Retinal fundus photograph, image size 1932x1916, 45° FOV — 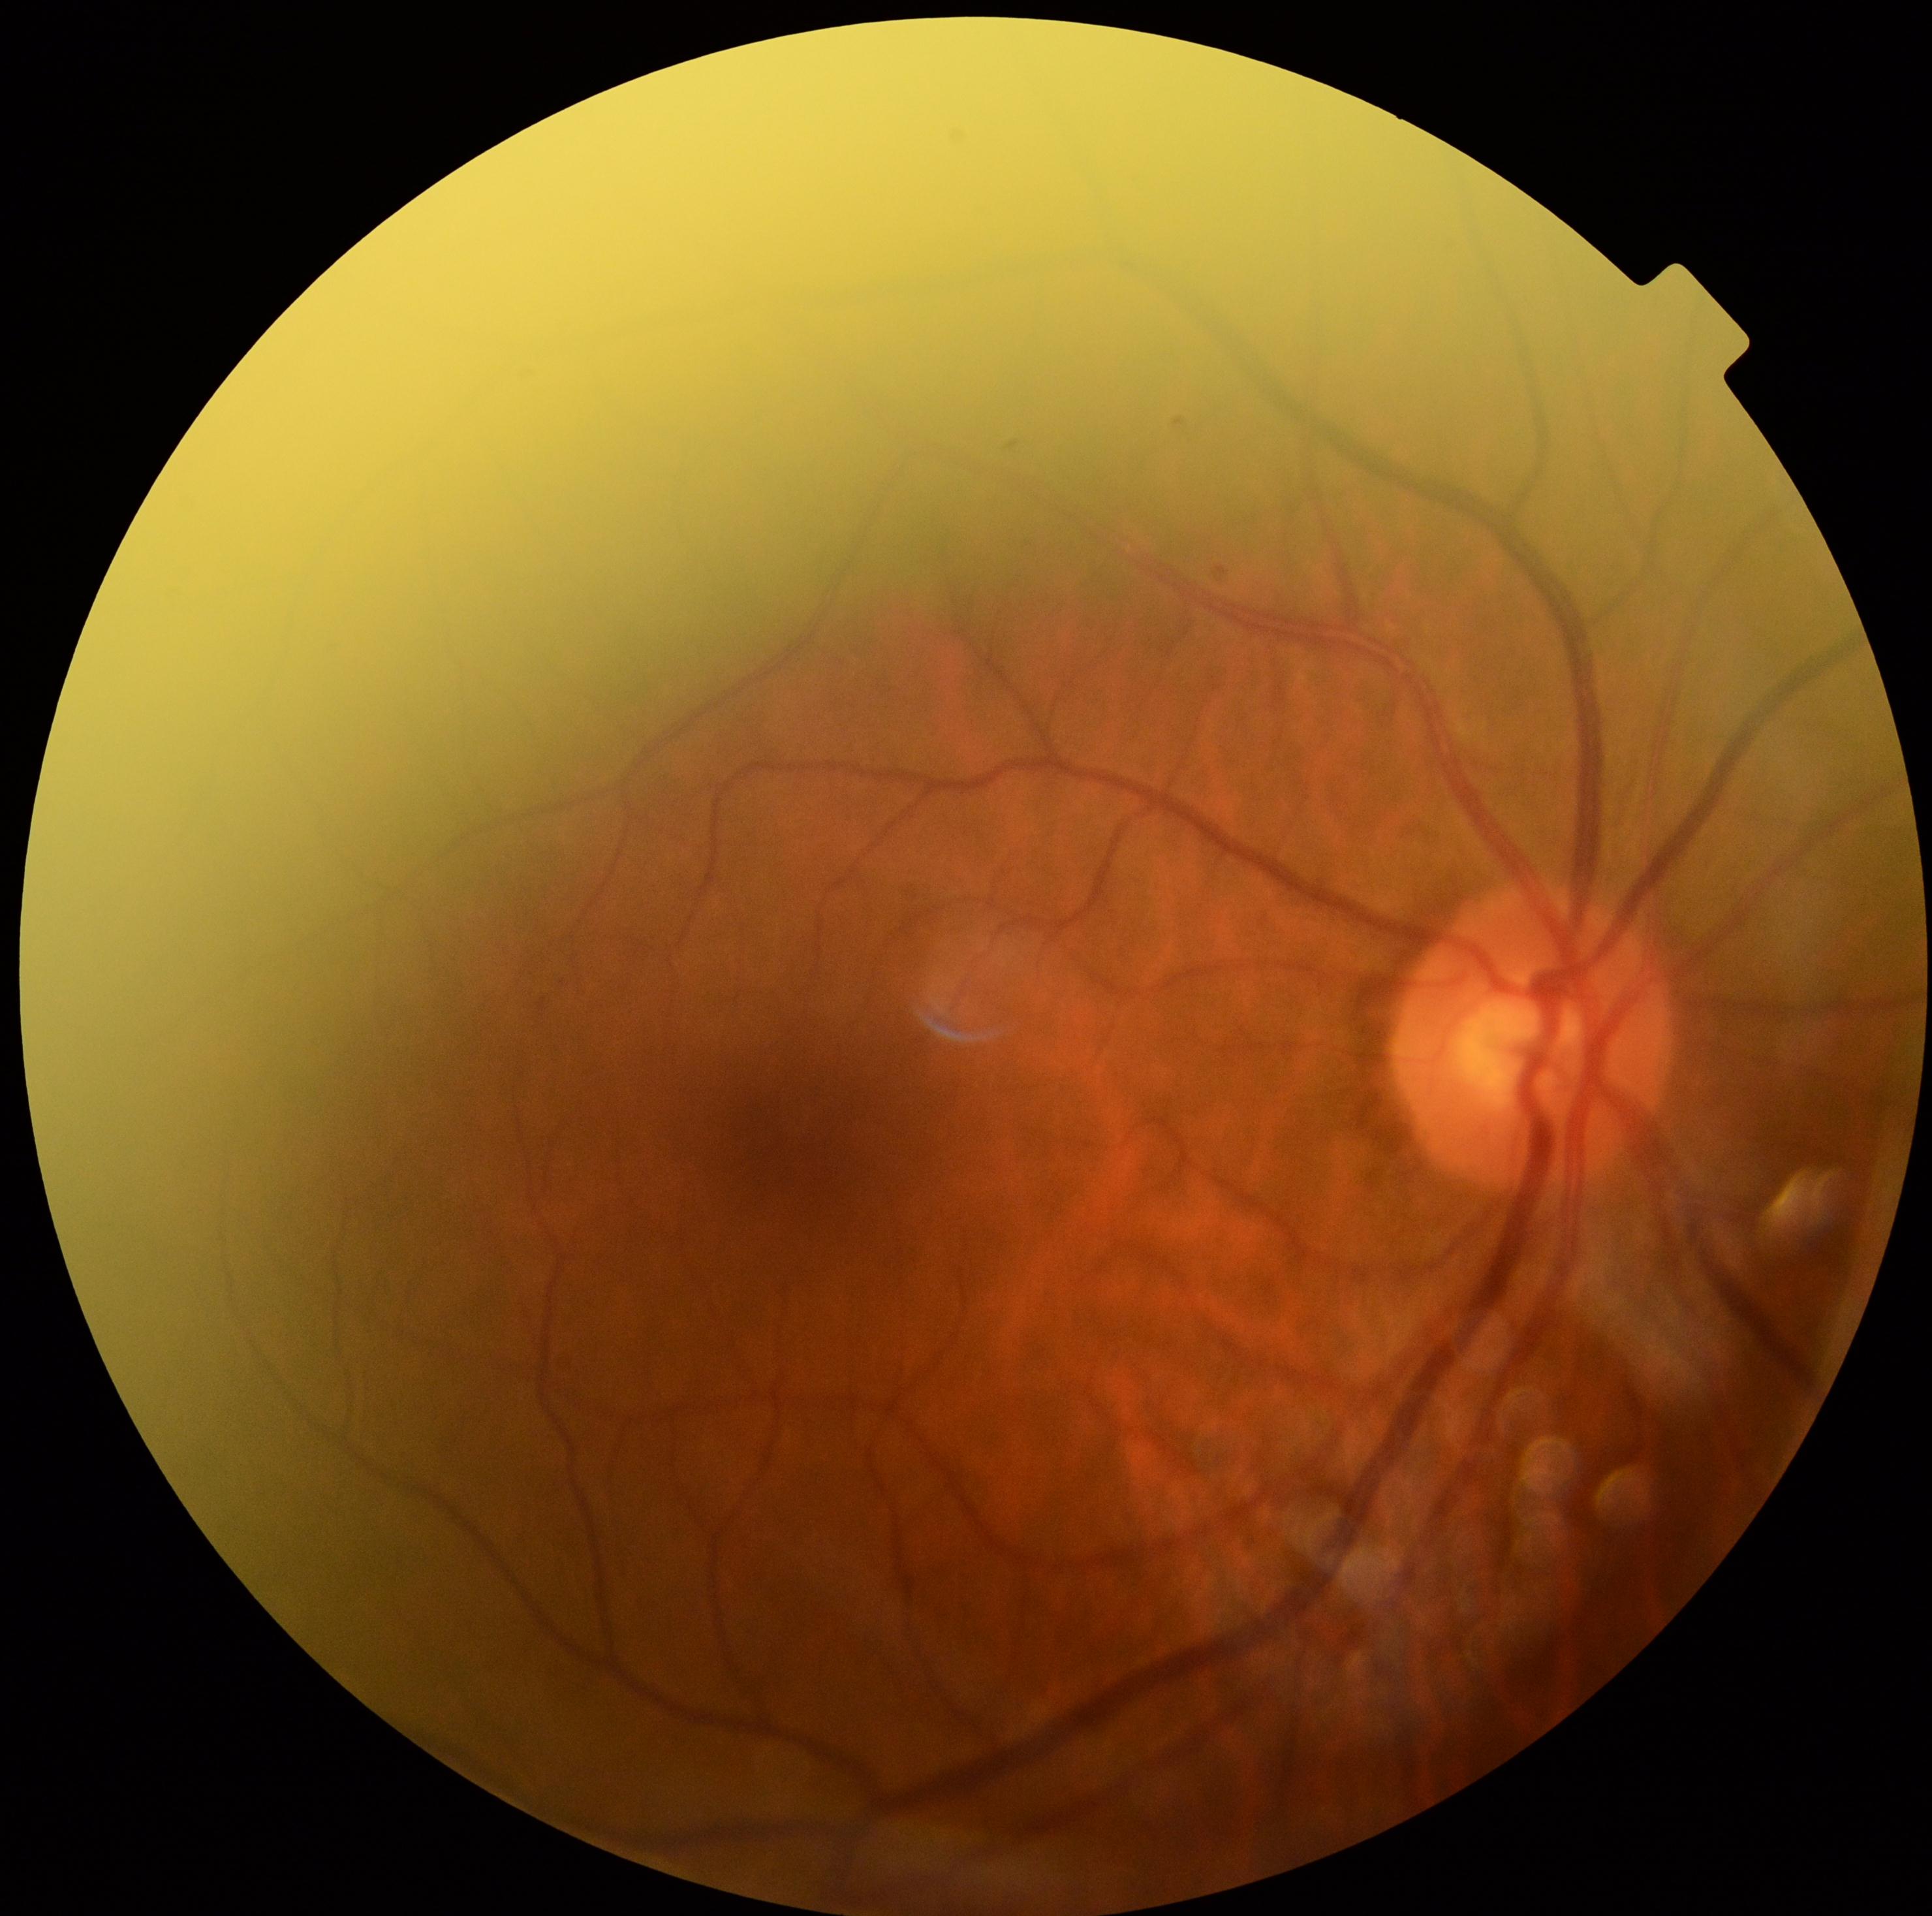
No diabetic retinal disease findings. Diabetic retinopathy severity: 0/4.